CFP · 1659x2212px.
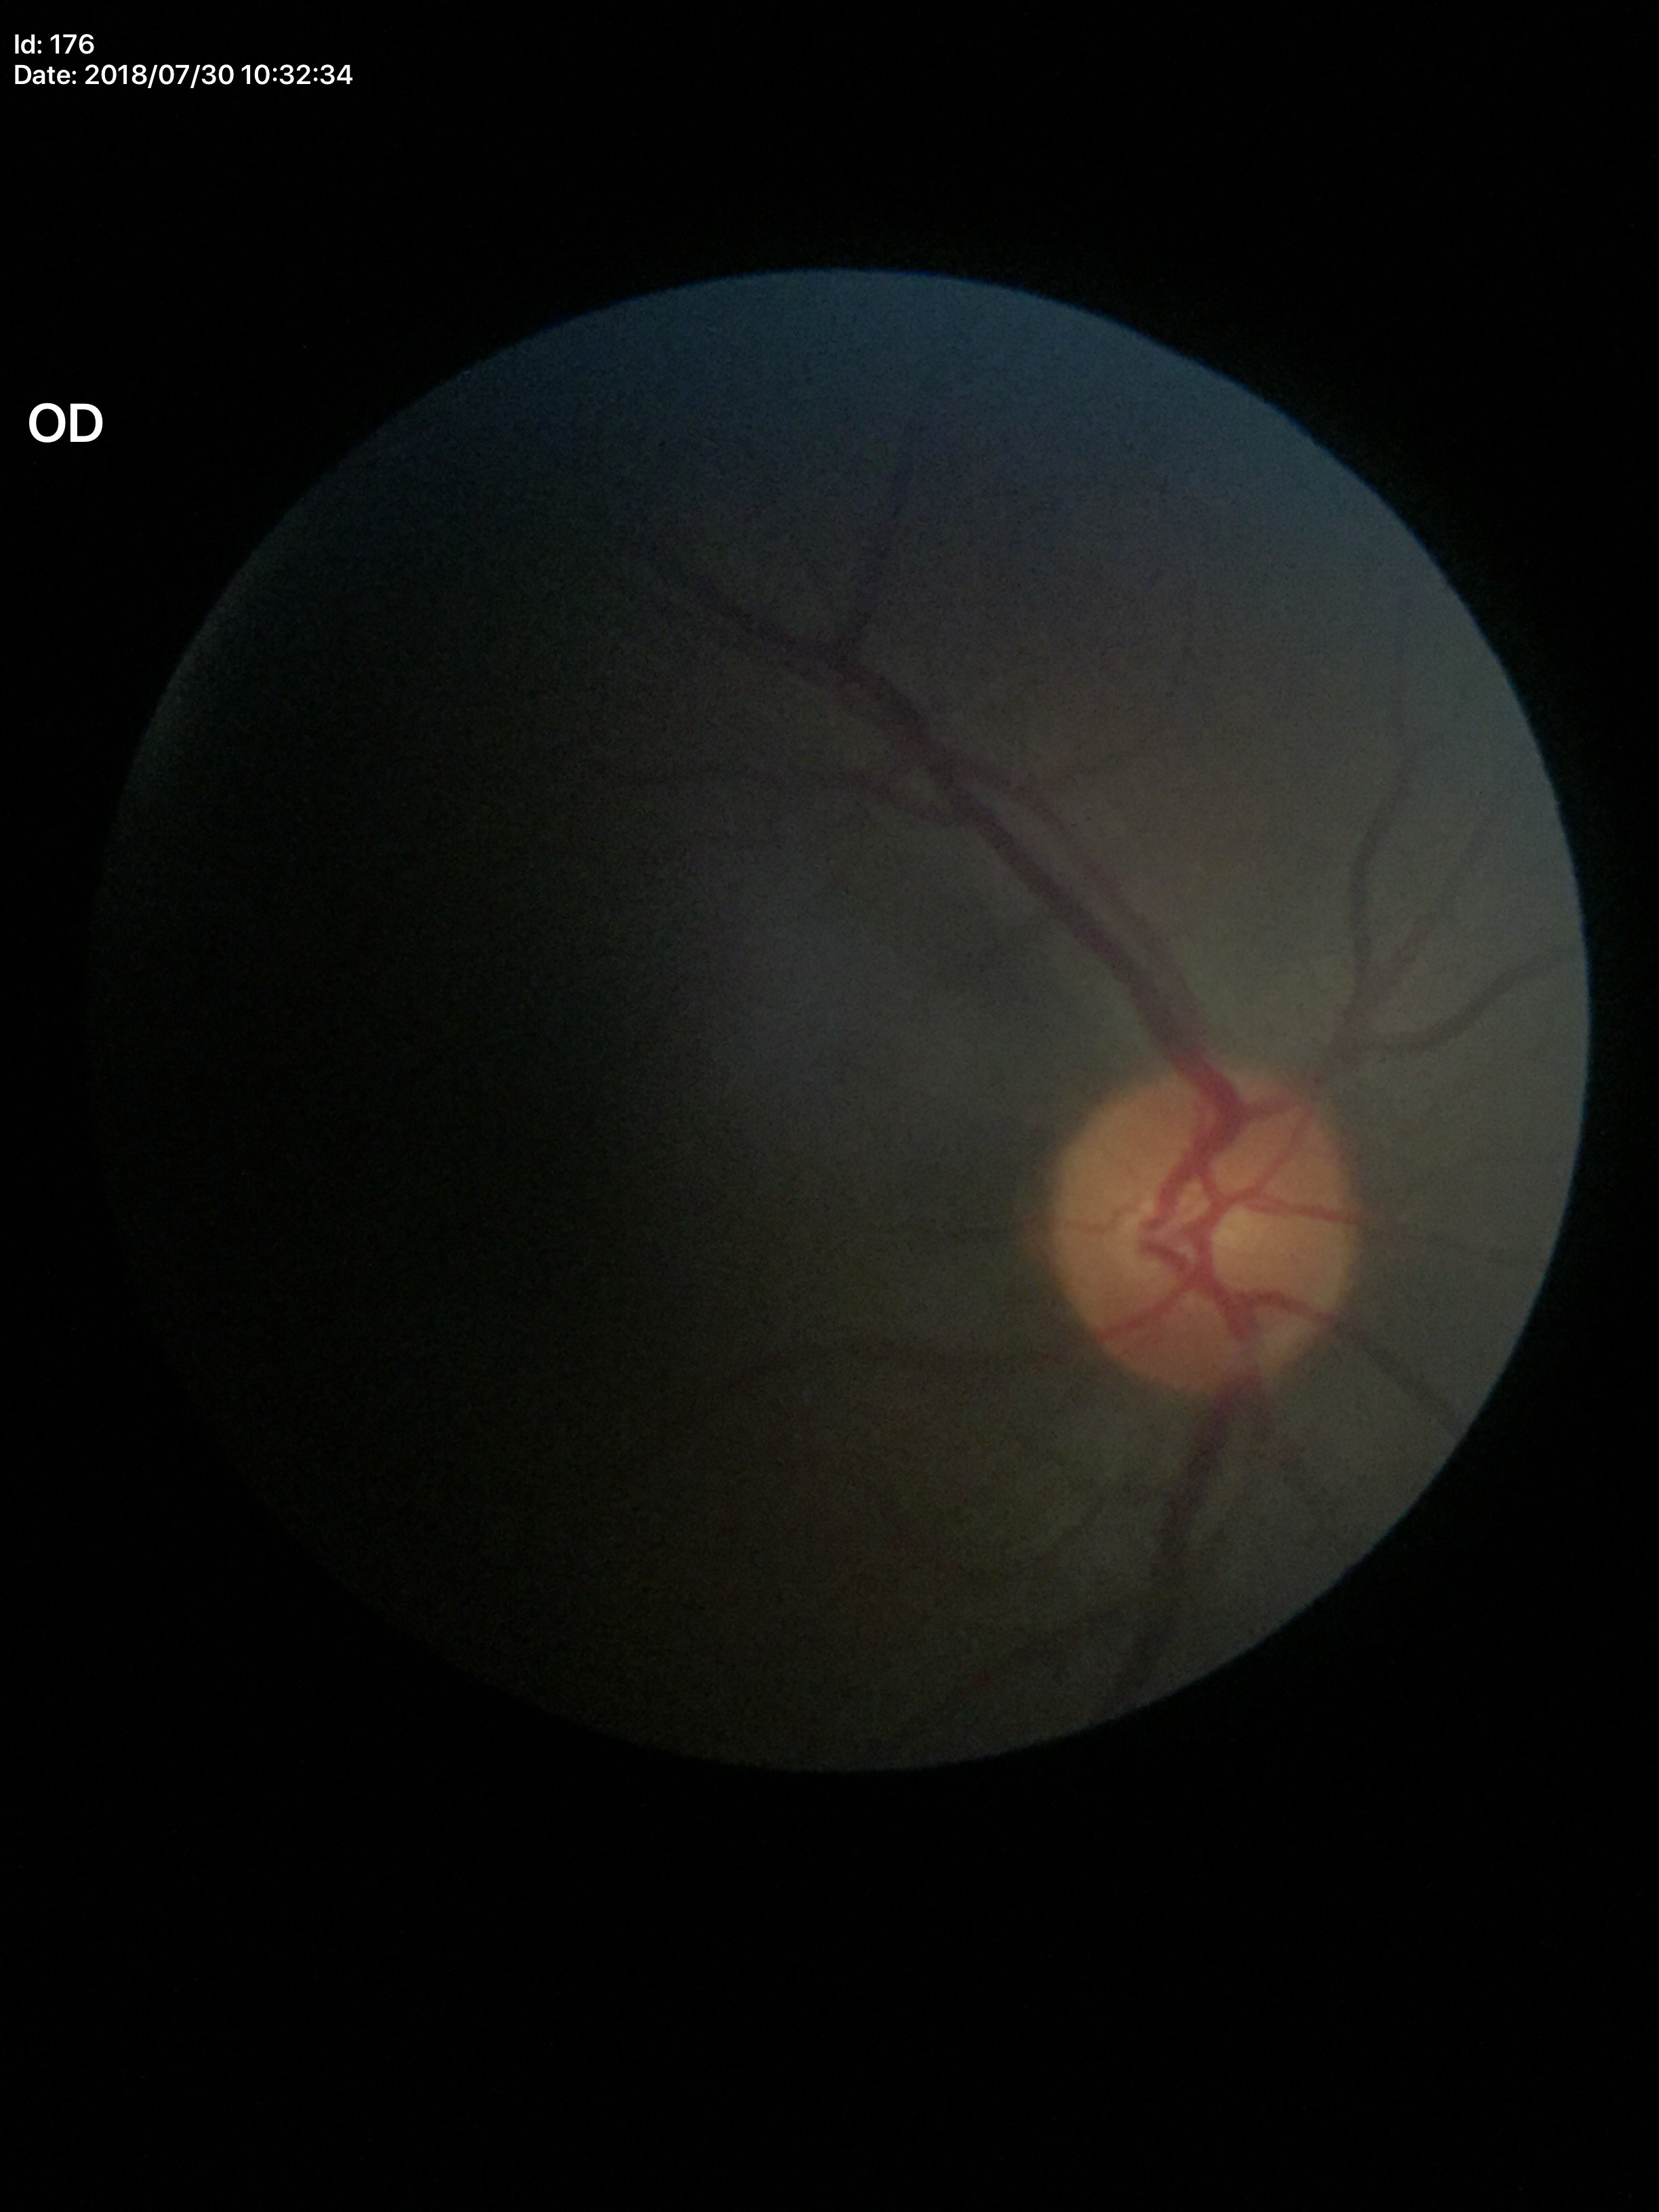

vertical C/D ratio (VCDR) = 0.45; Glaucoma evaluation = not suspect (all 5 graders called normal); area CDR (ACDR) = 0.23.